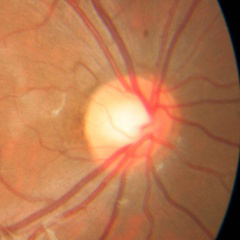 No glaucomatous optic neuropathy.